2352 by 1568 pixels: 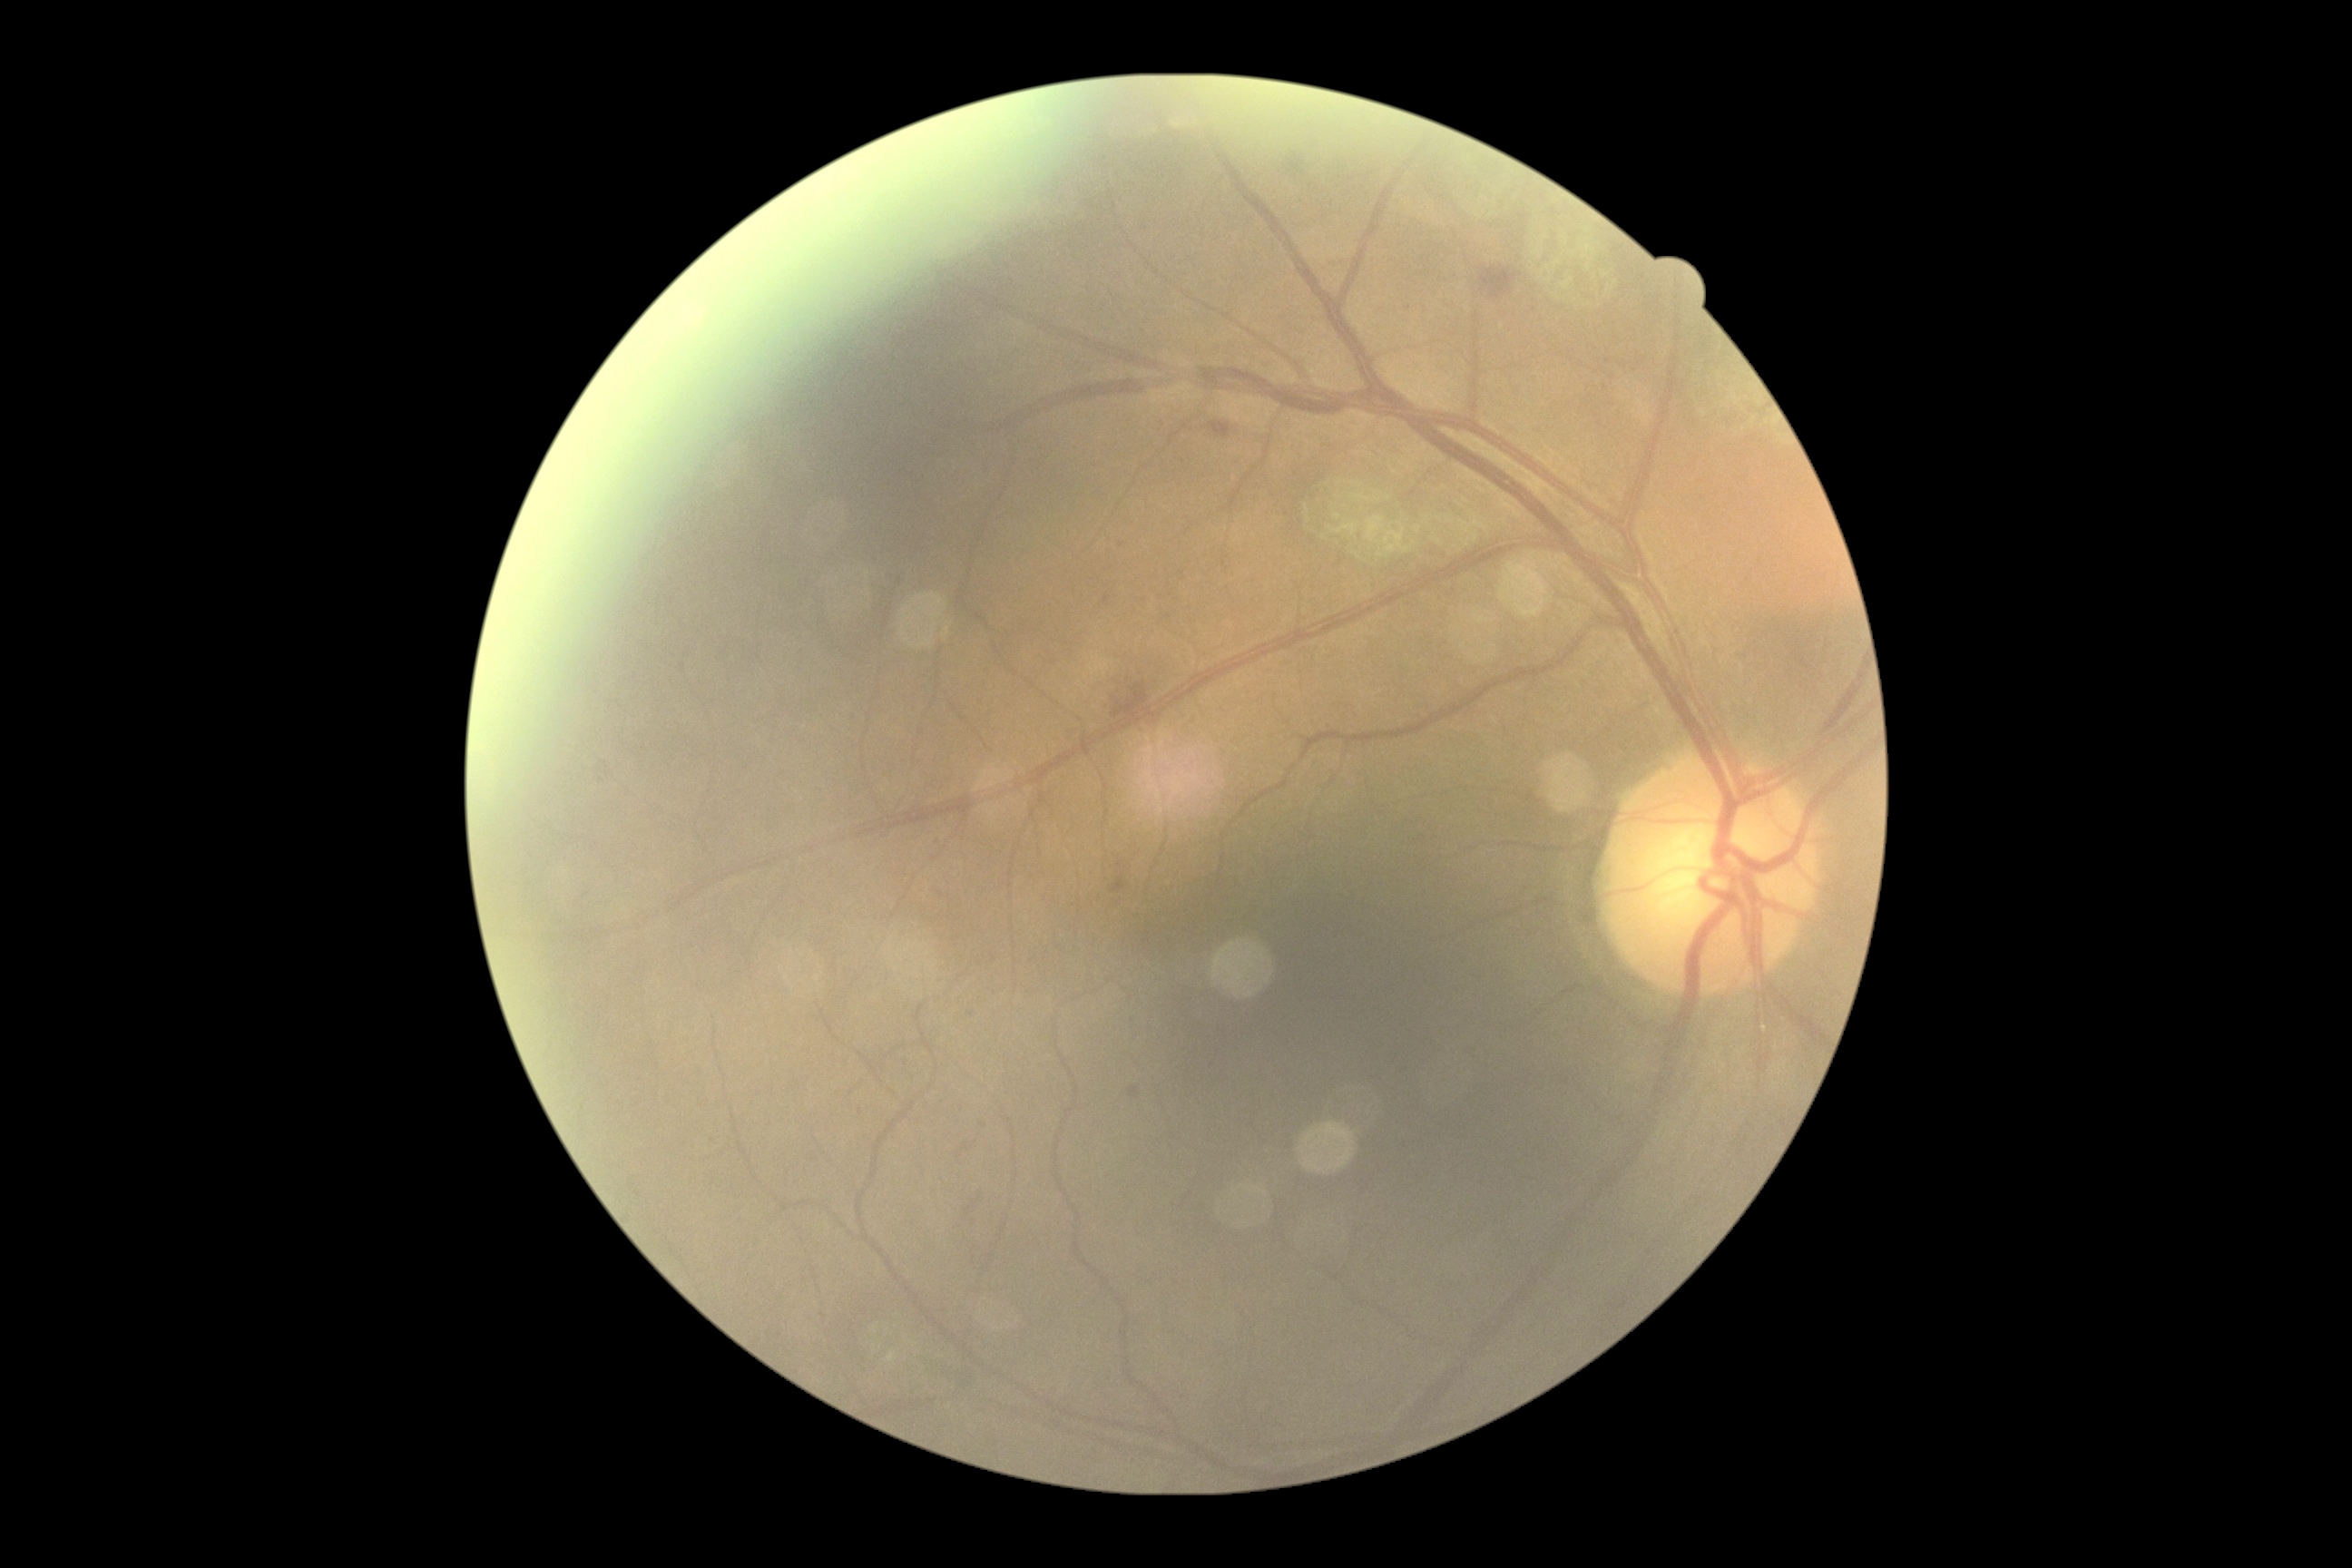

Diabetic retinopathy is grade 2 (moderate NPDR). The retinopathy is classified as non-proliferative diabetic retinopathy.